Pediatric wide-field fundus photograph
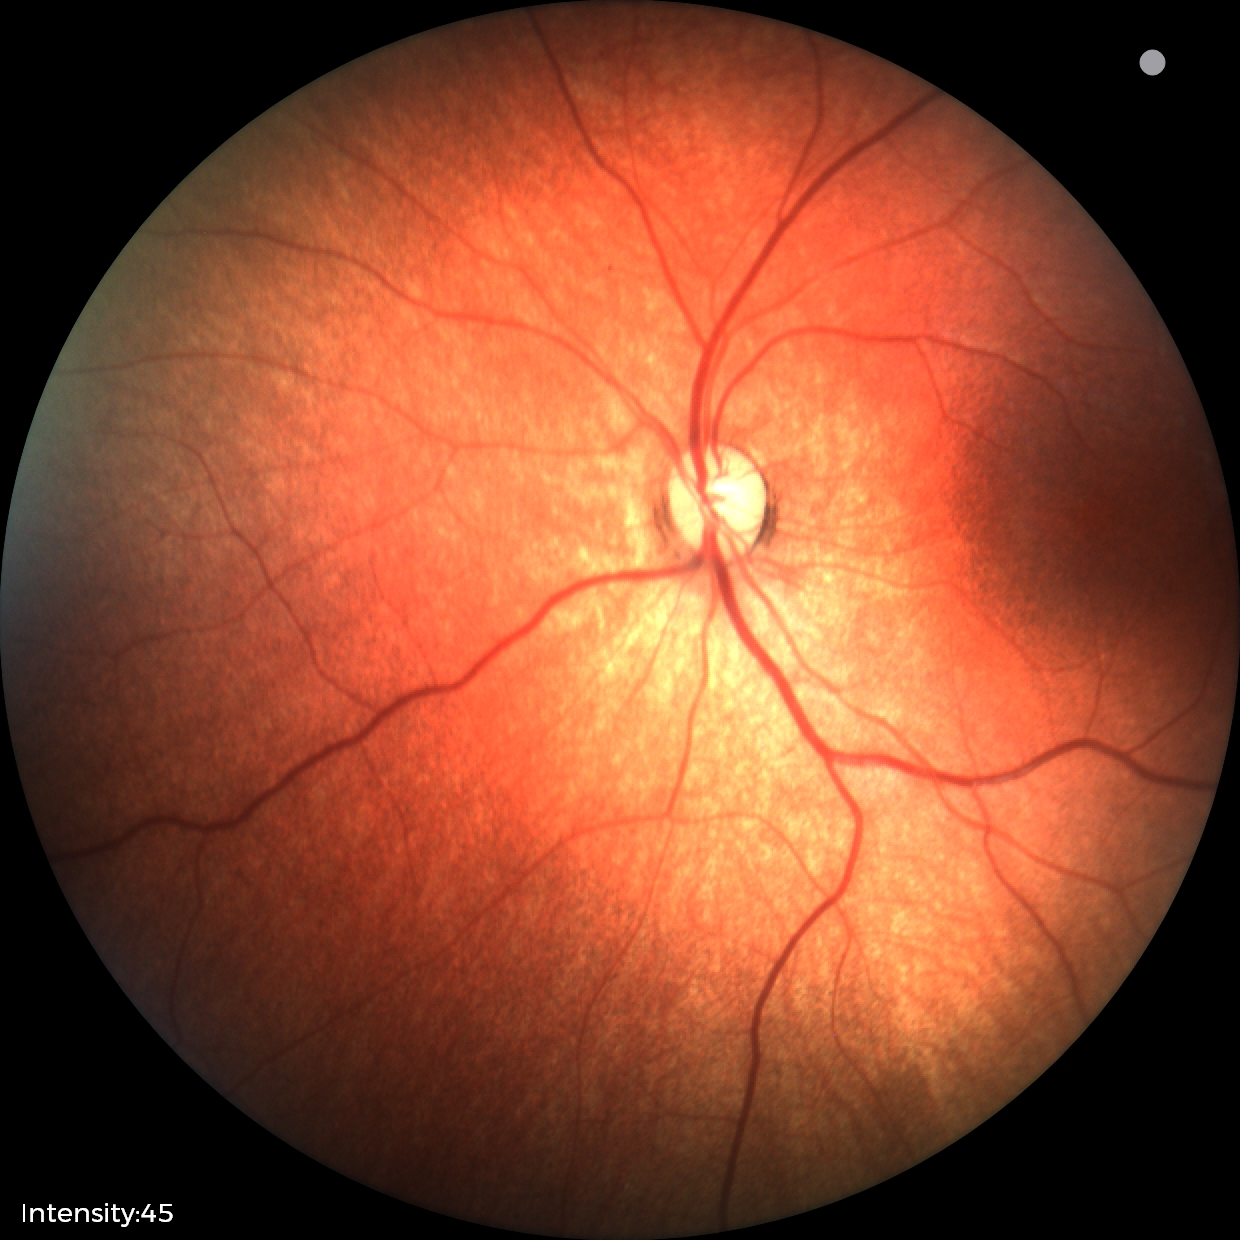
Impression = normal retinal appearance.